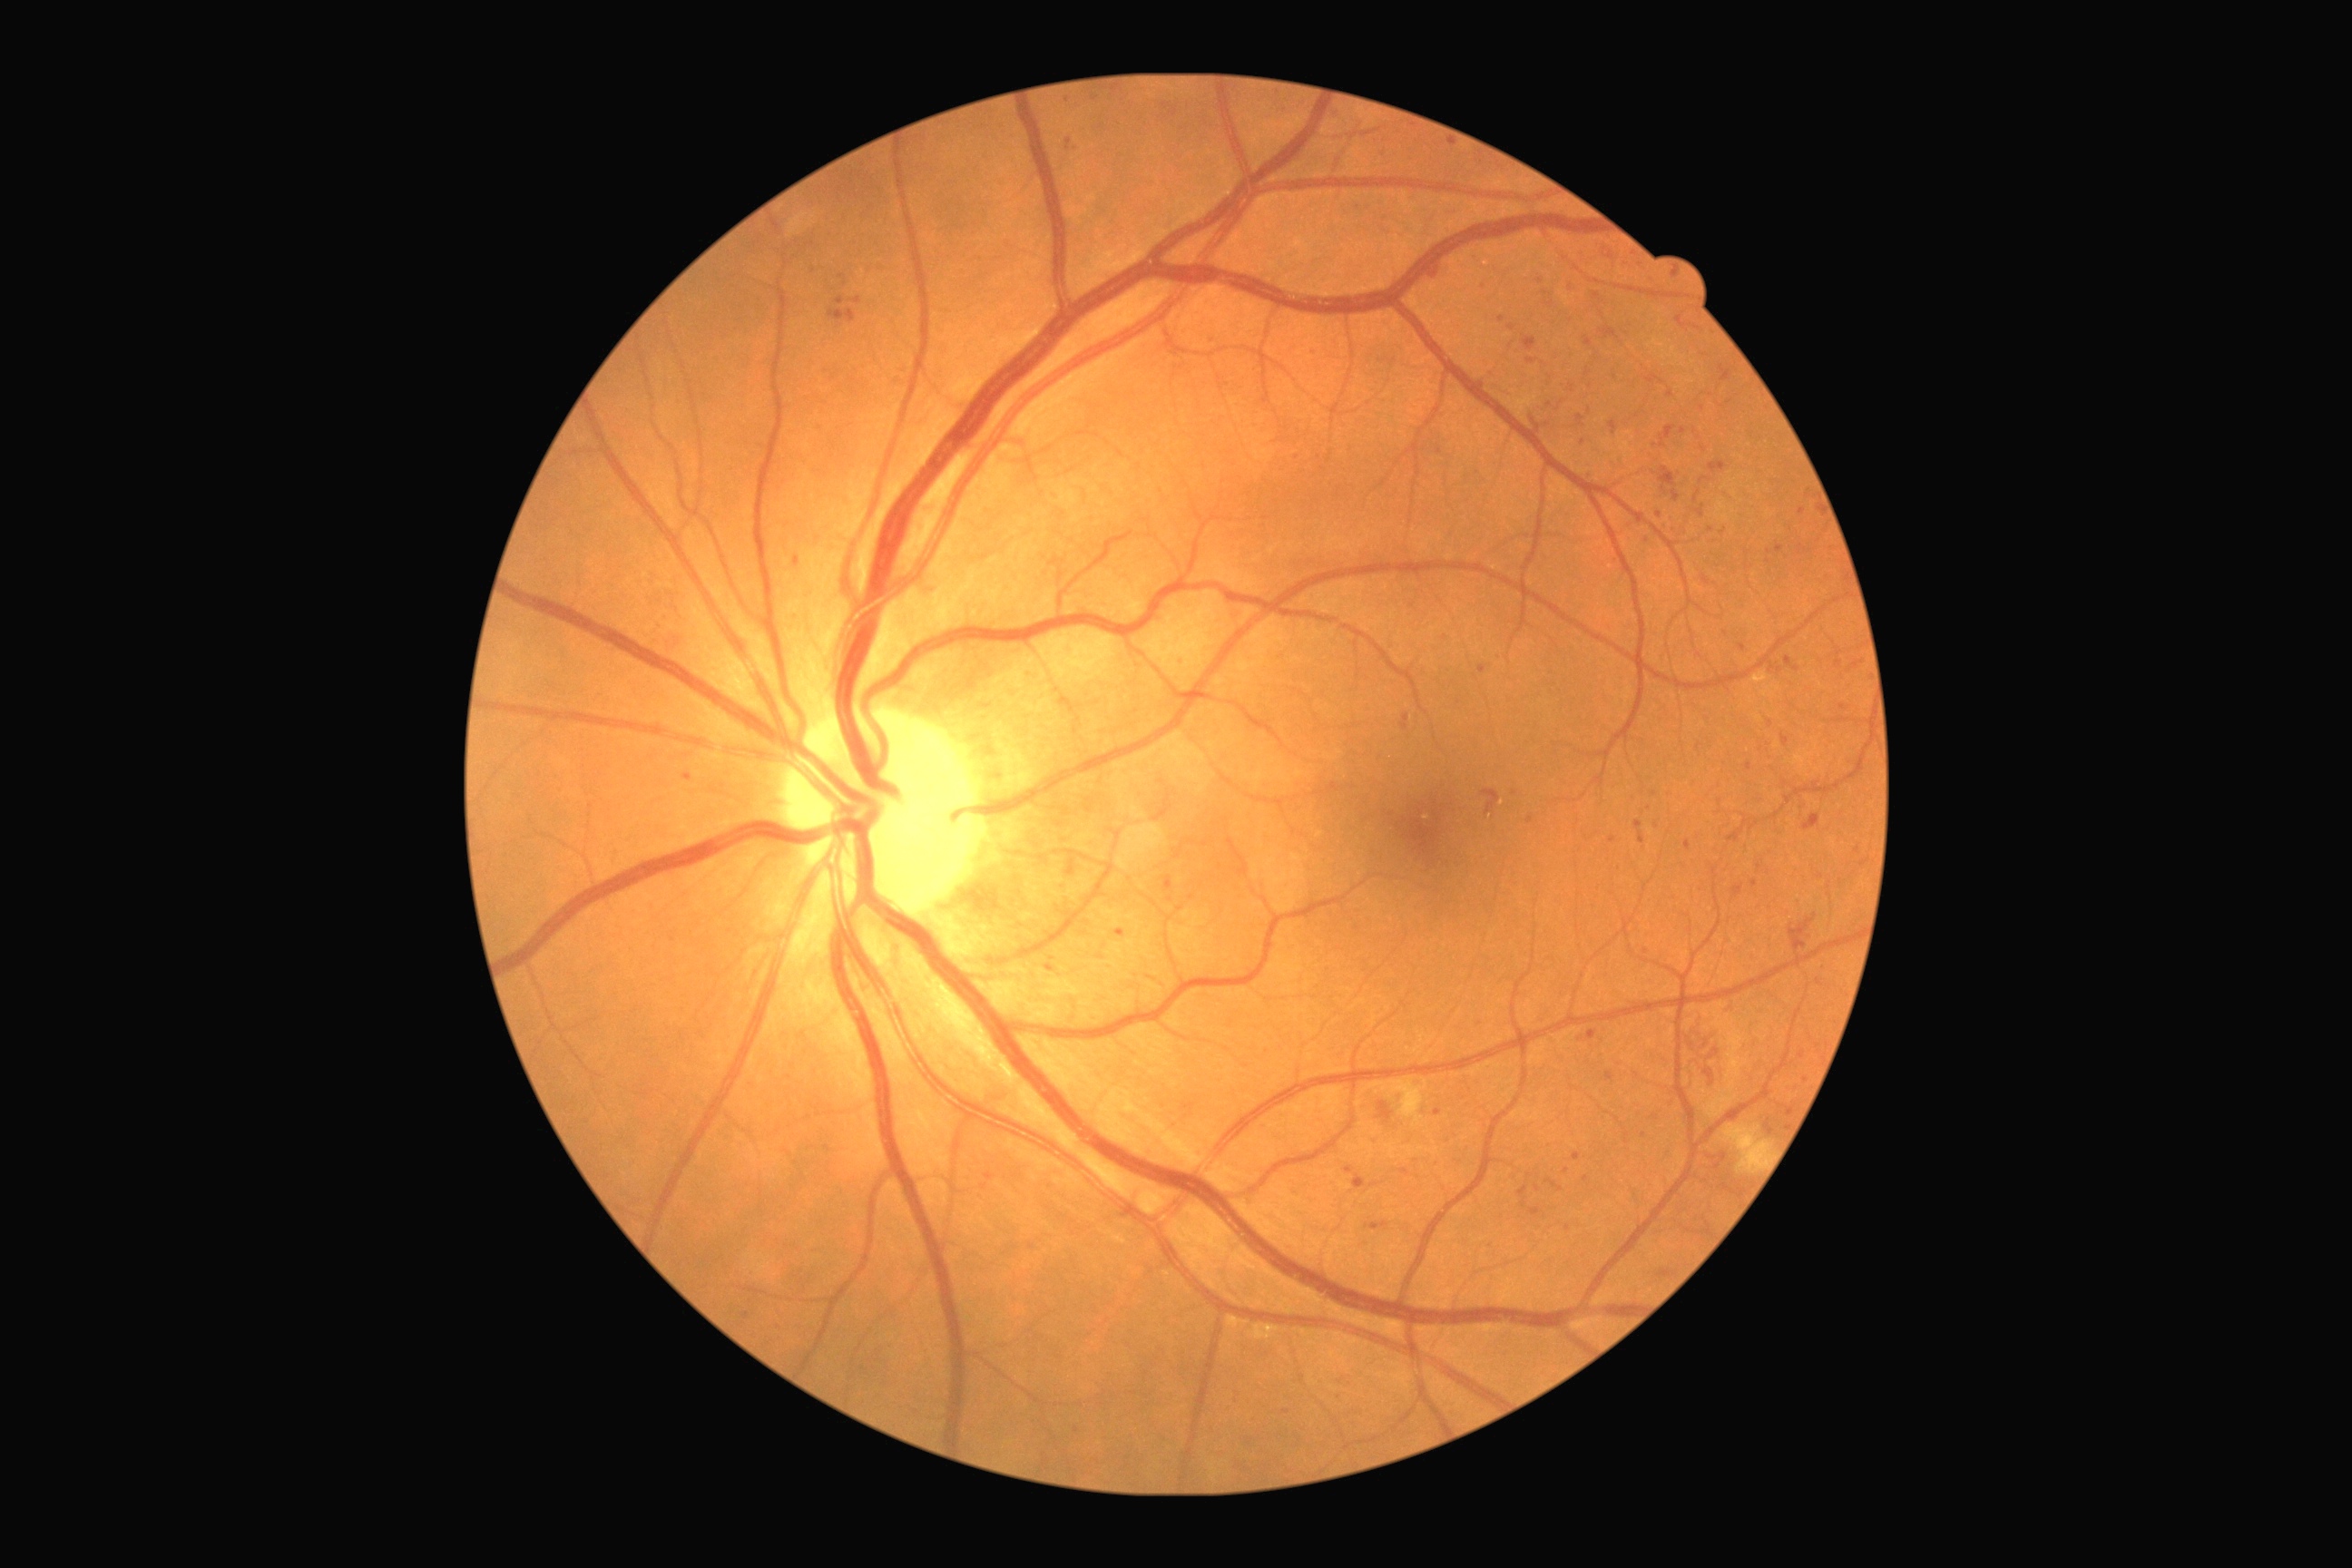
Diabetic retinopathy (DR): grade 3.
Disease class: non-proliferative diabetic retinopathy.